Acquired on the Clarity RetCam 3. RetCam wide-field infant fundus image:
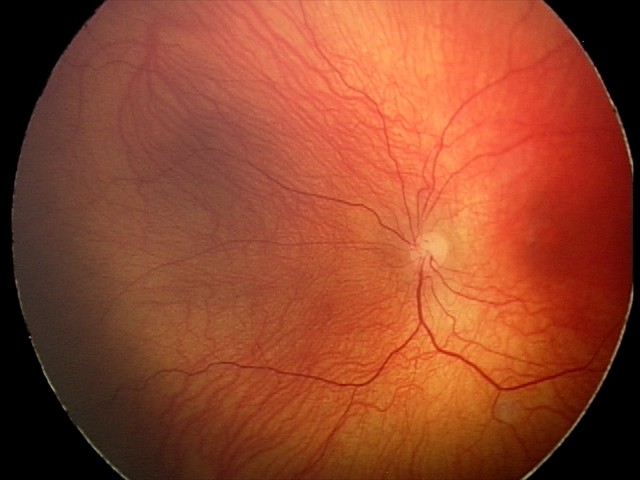
Without plus disease. Screening series with status post retinopathy of prematurity — retinal appearance after treated retinopathy of prematurity.